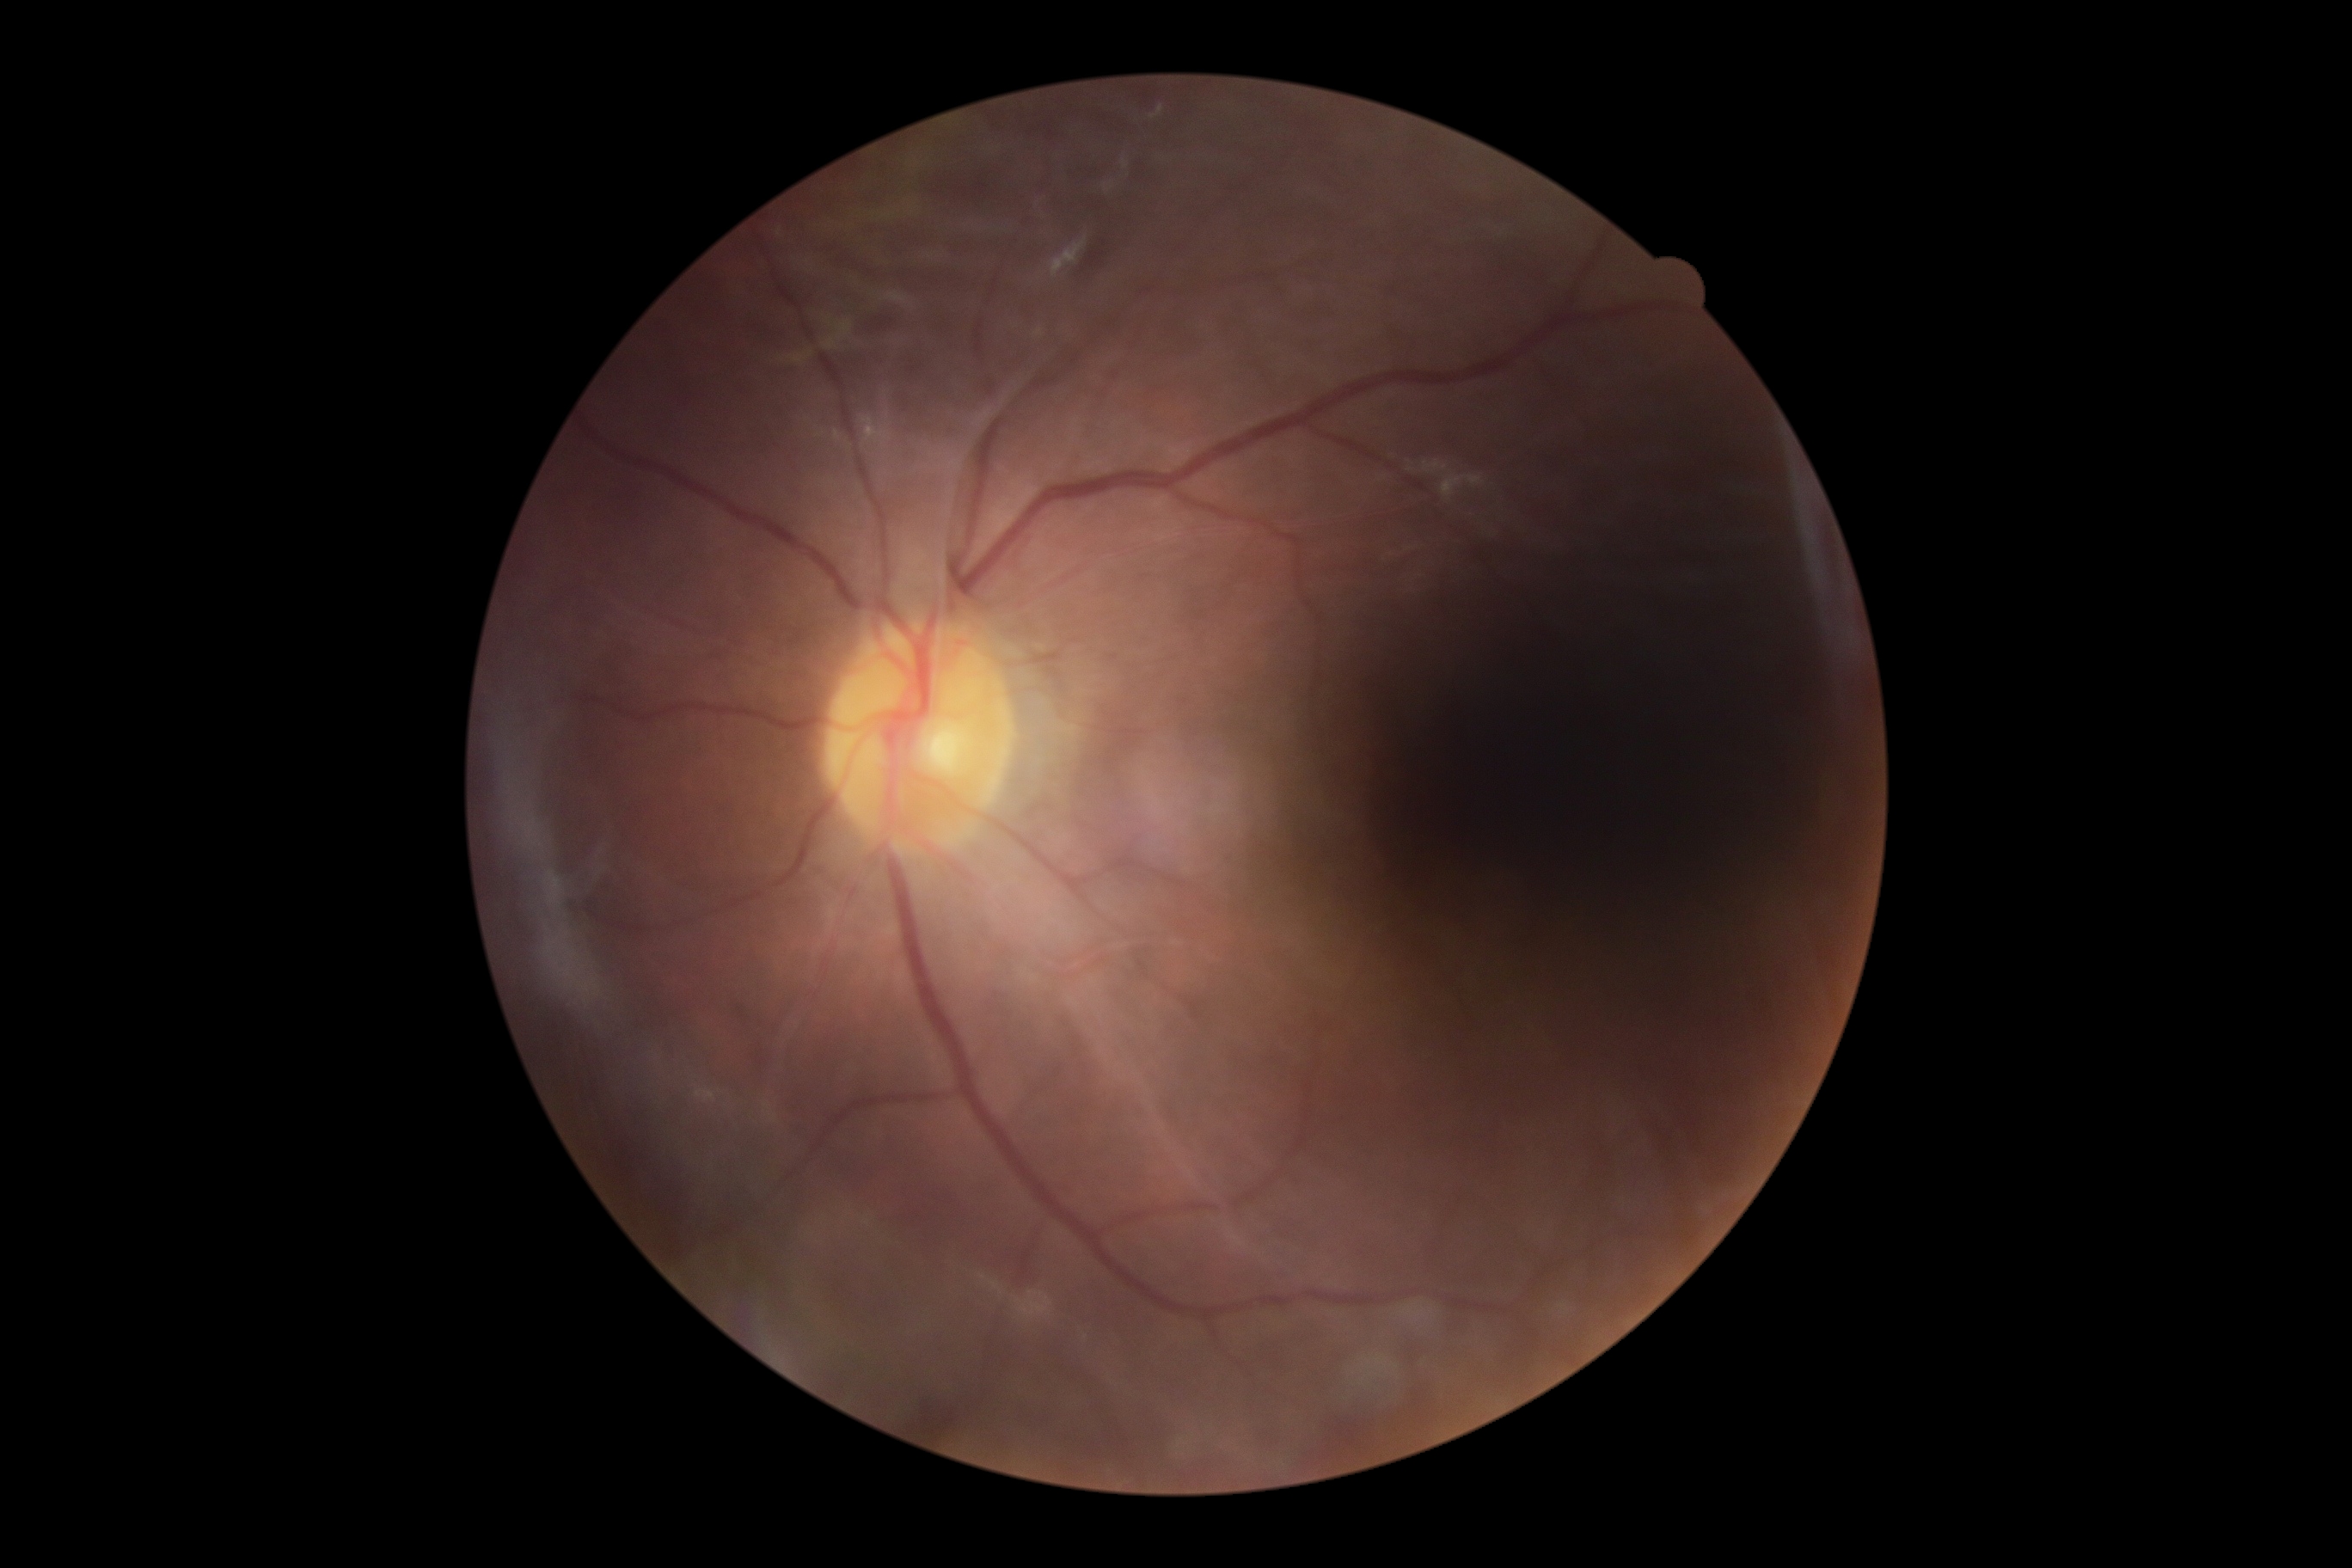

The retinopathy is classified as proliferative diabetic retinopathy. Diabetic retinopathy grade is proliferative diabetic retinopathy (4) — neovascularization and/or vitreous/pre-retinal hemorrhage.